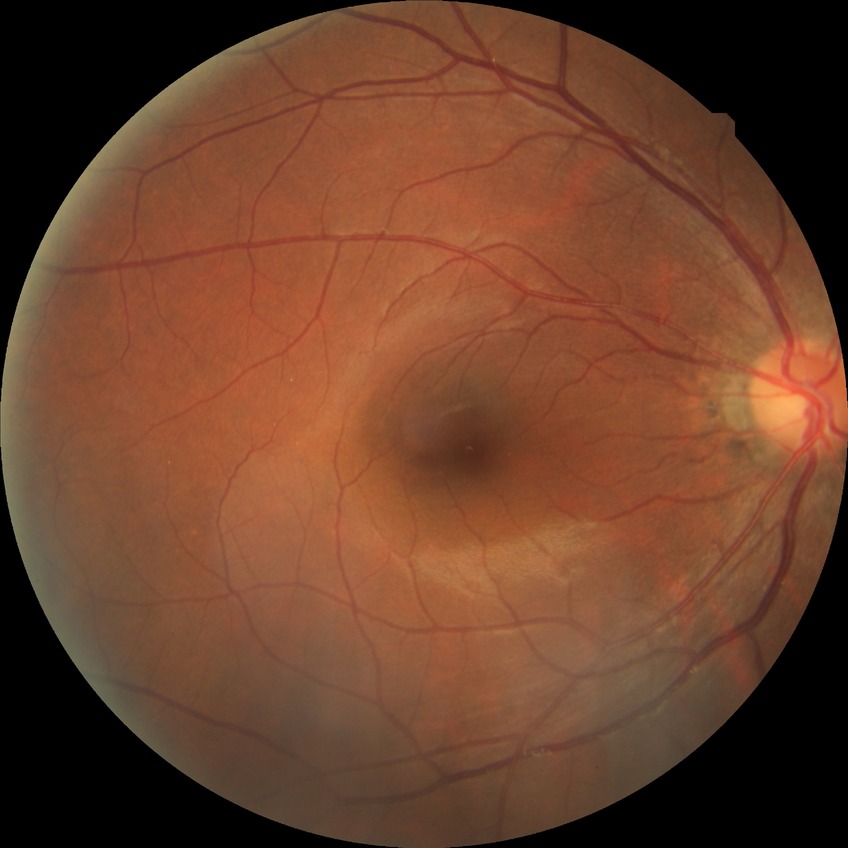

DR stage: NDR.